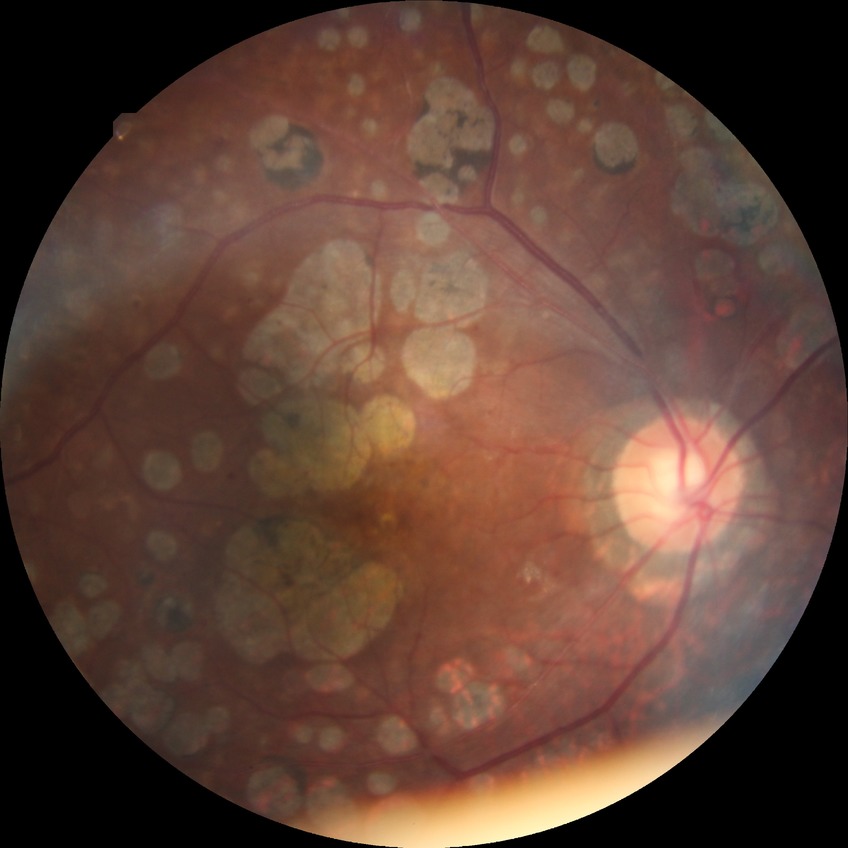 diabetic retinopathy severity = proliferative diabetic retinopathy